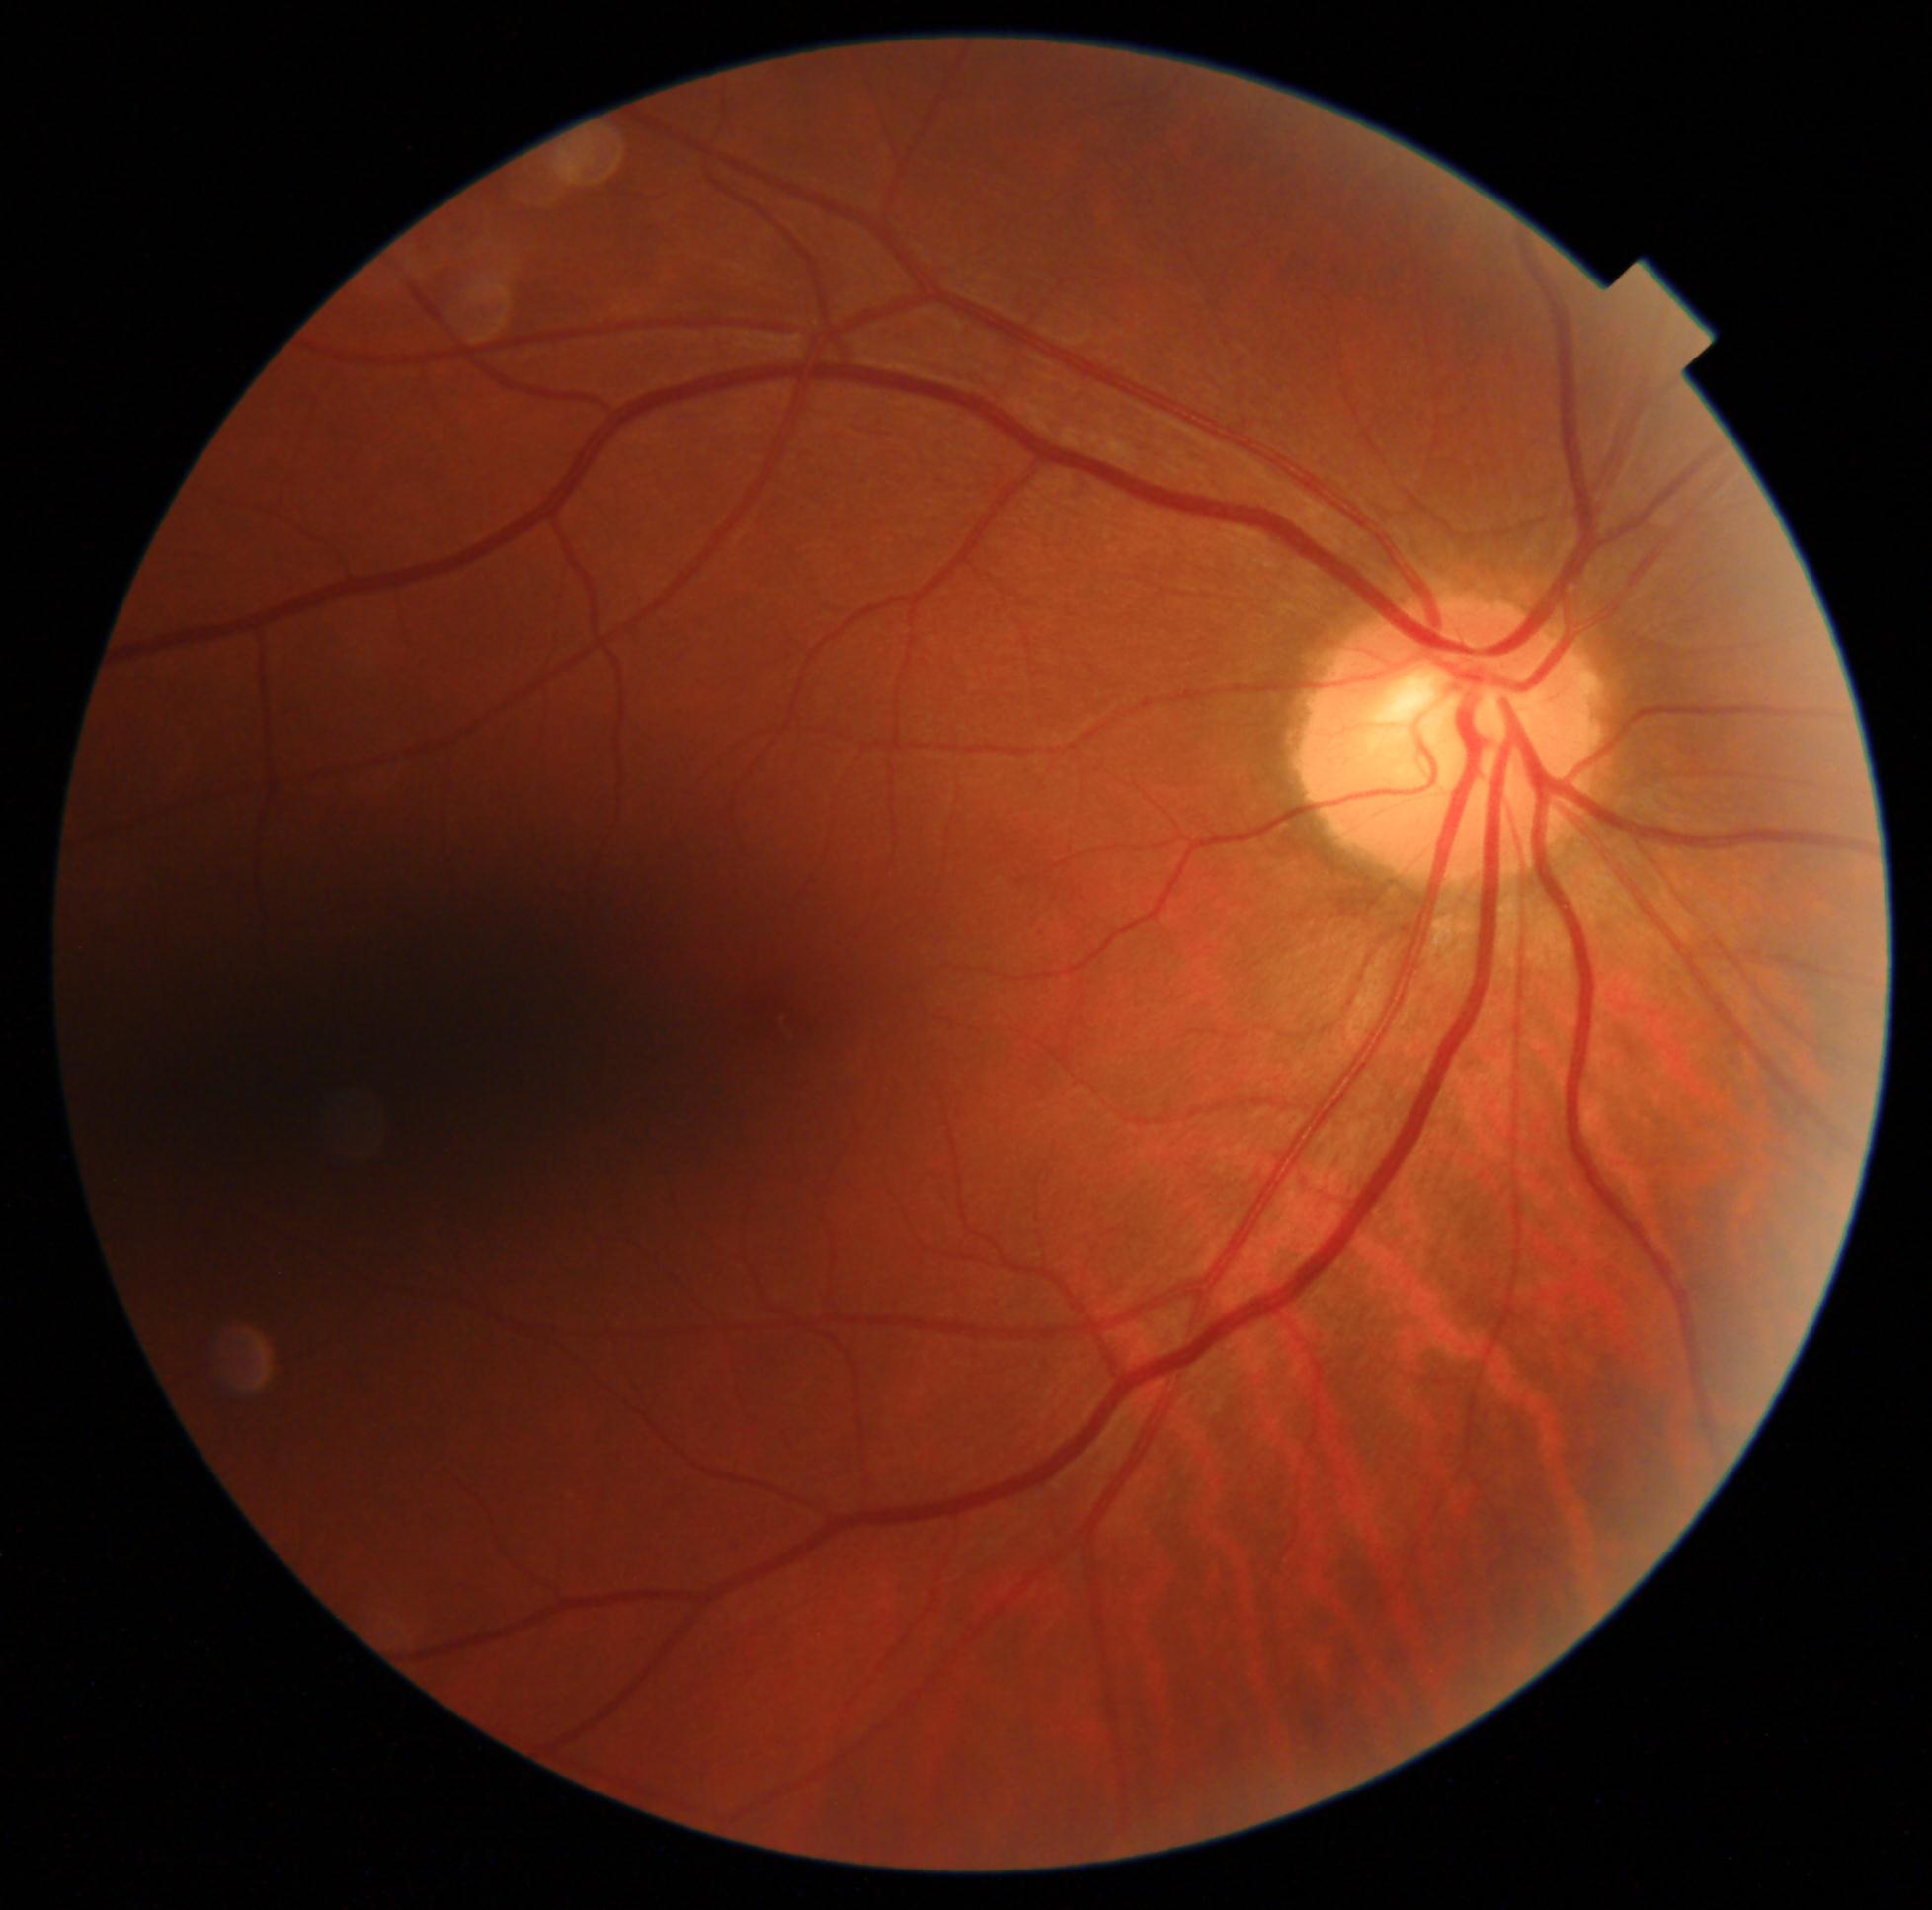

DR stage is no apparent diabetic retinopathy (grade 0). No apparent diabetic retinopathy.